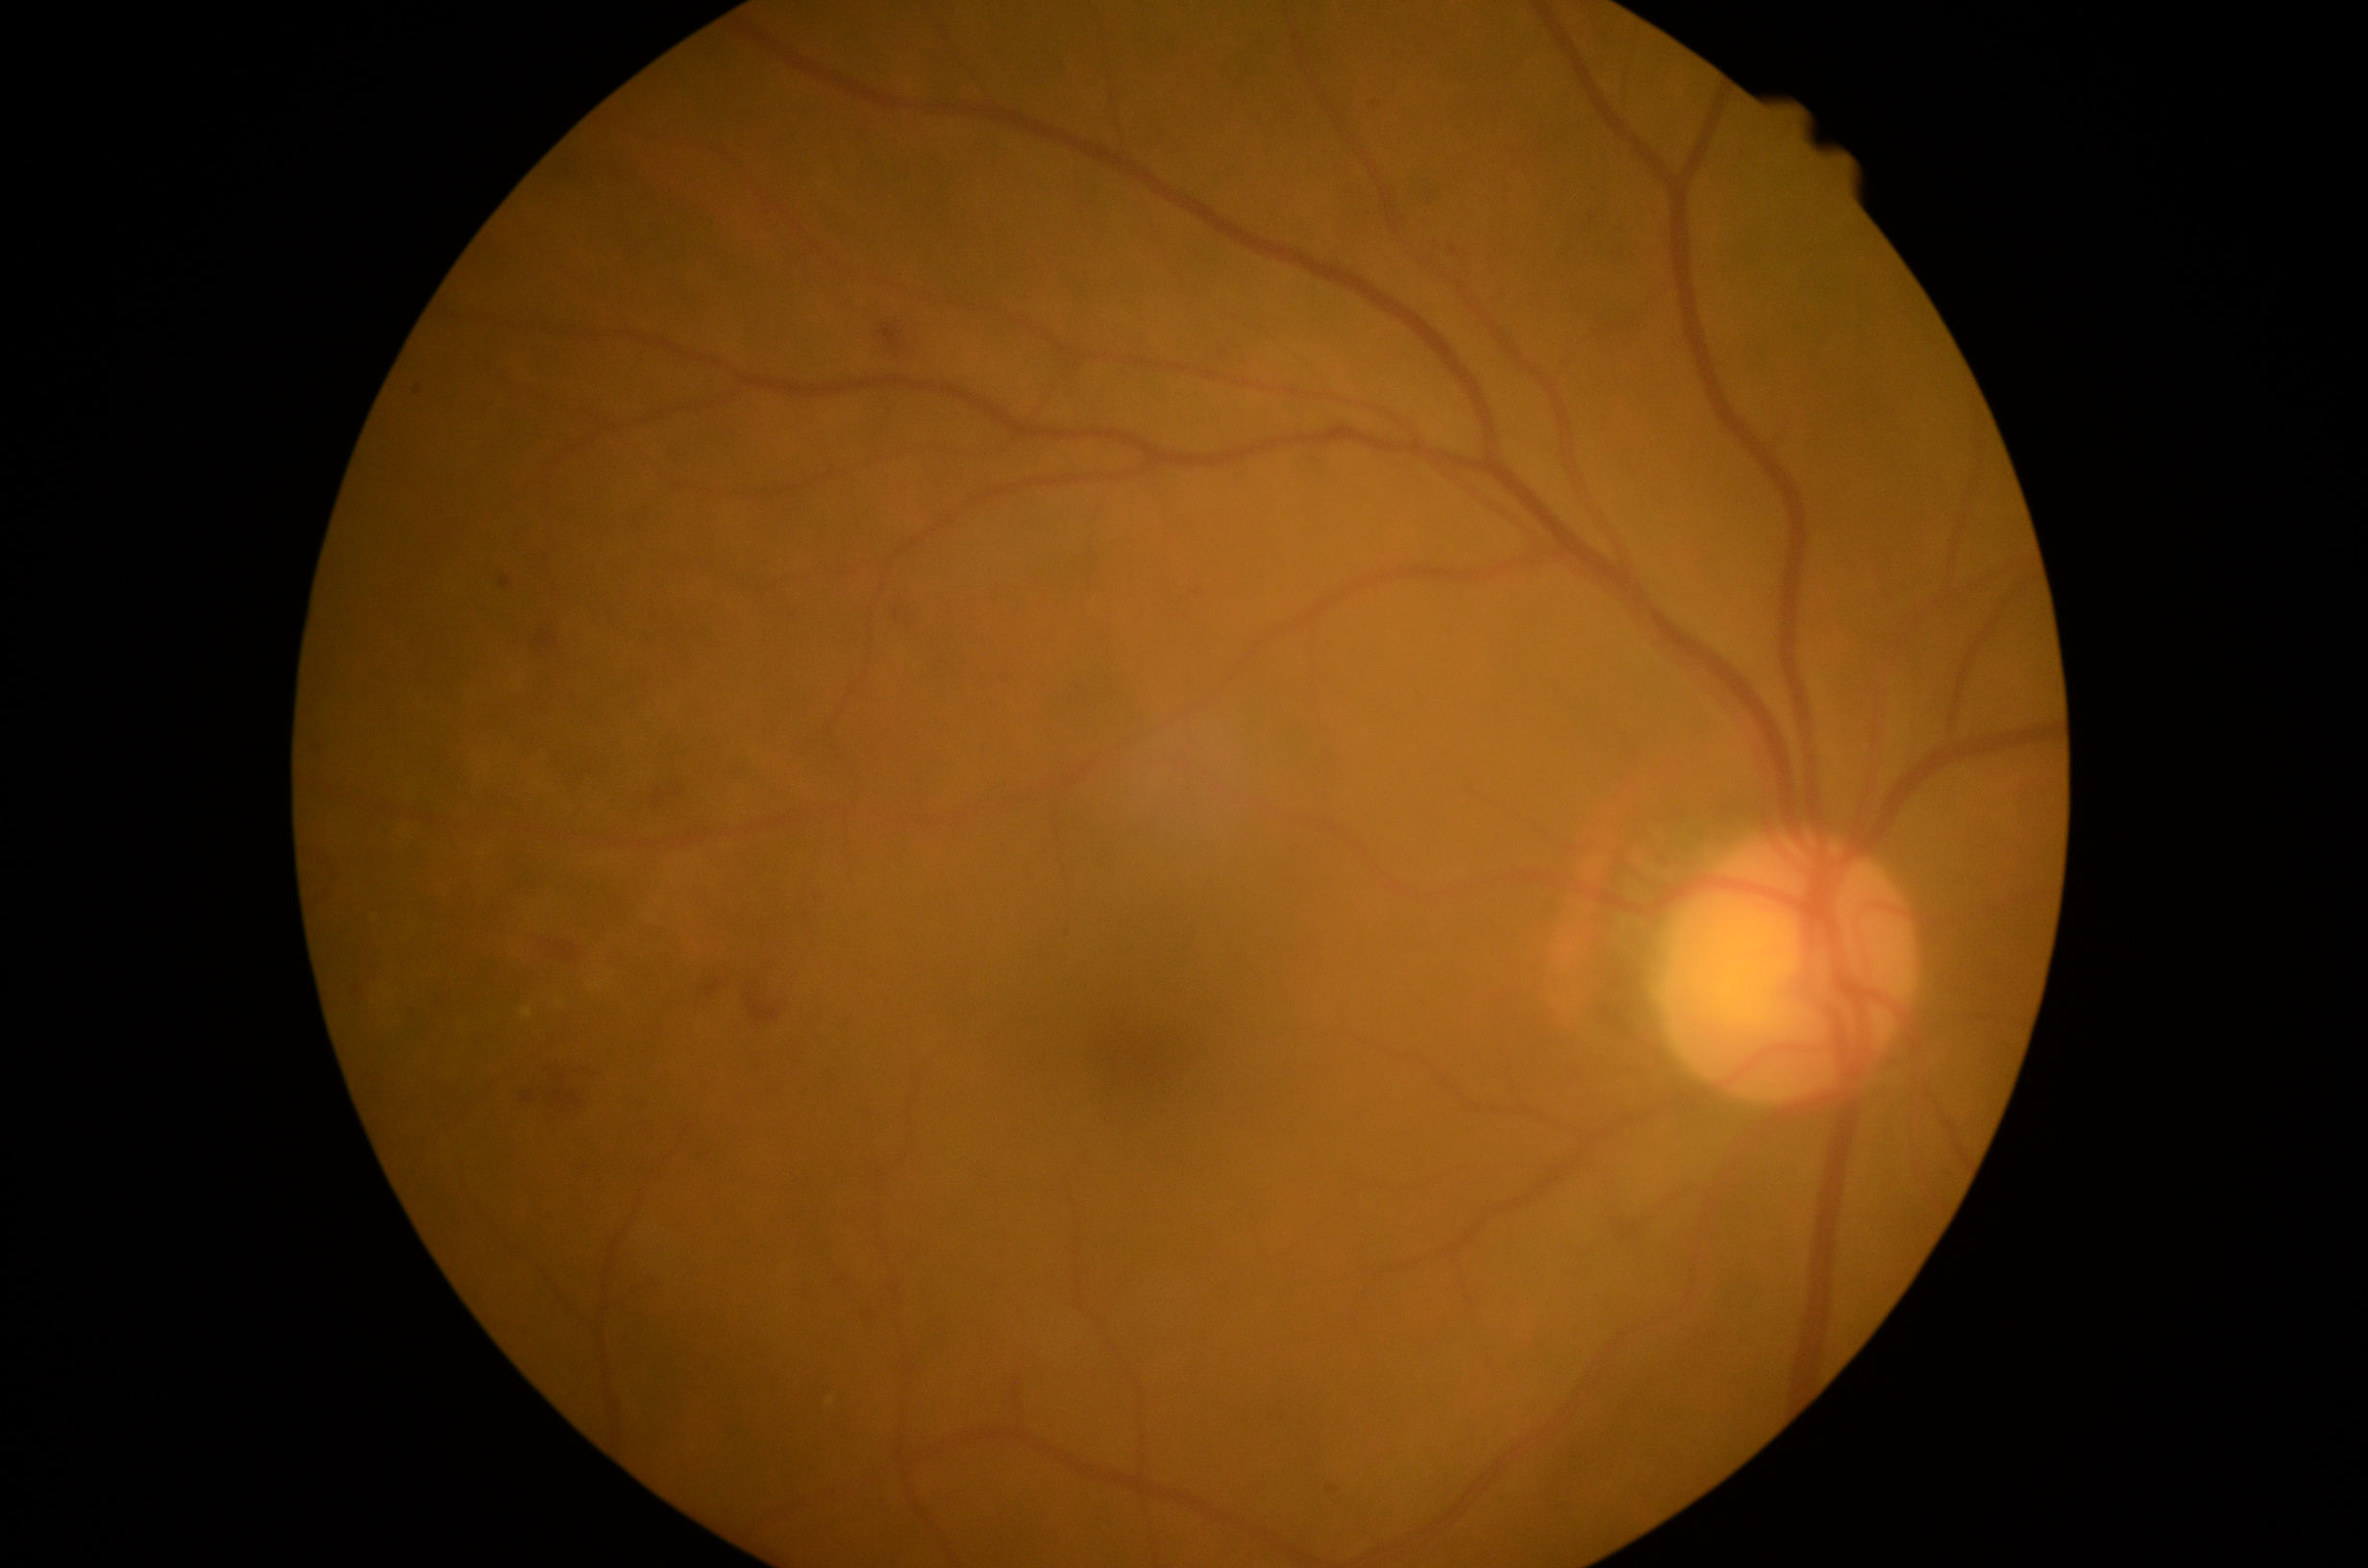 Diabetic retinopathy (DR) is moderate non-proliferative diabetic retinopathy (grade 2).